Color fundus image
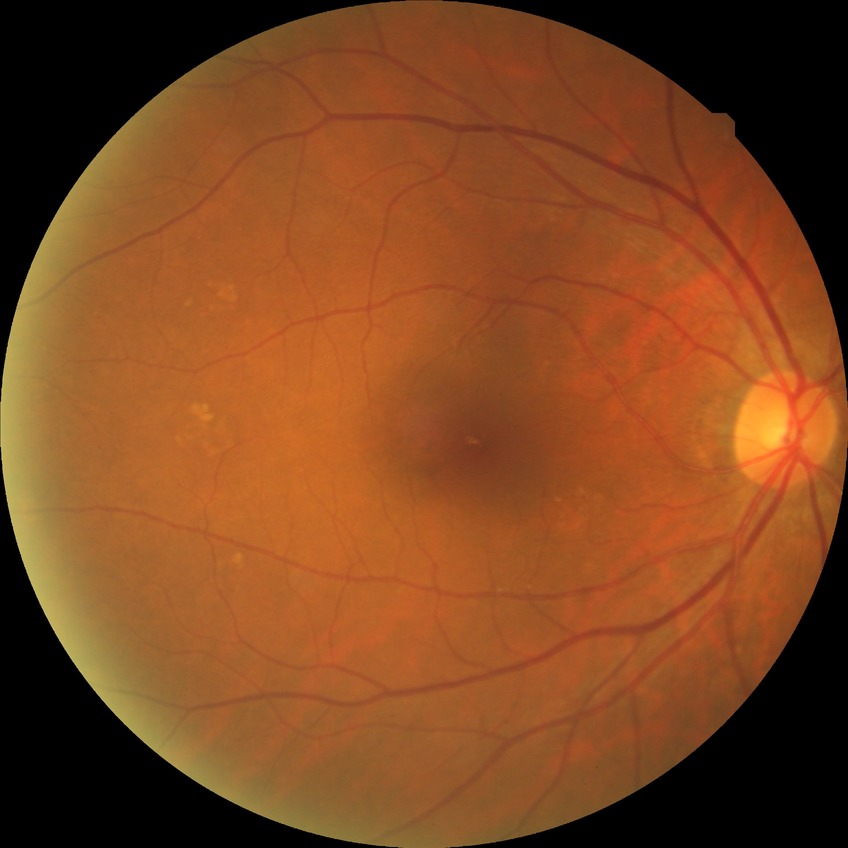 diabetic retinopathy (DR) = NDR (no diabetic retinopathy).